Retinal fundus photograph; modified Davis grading:
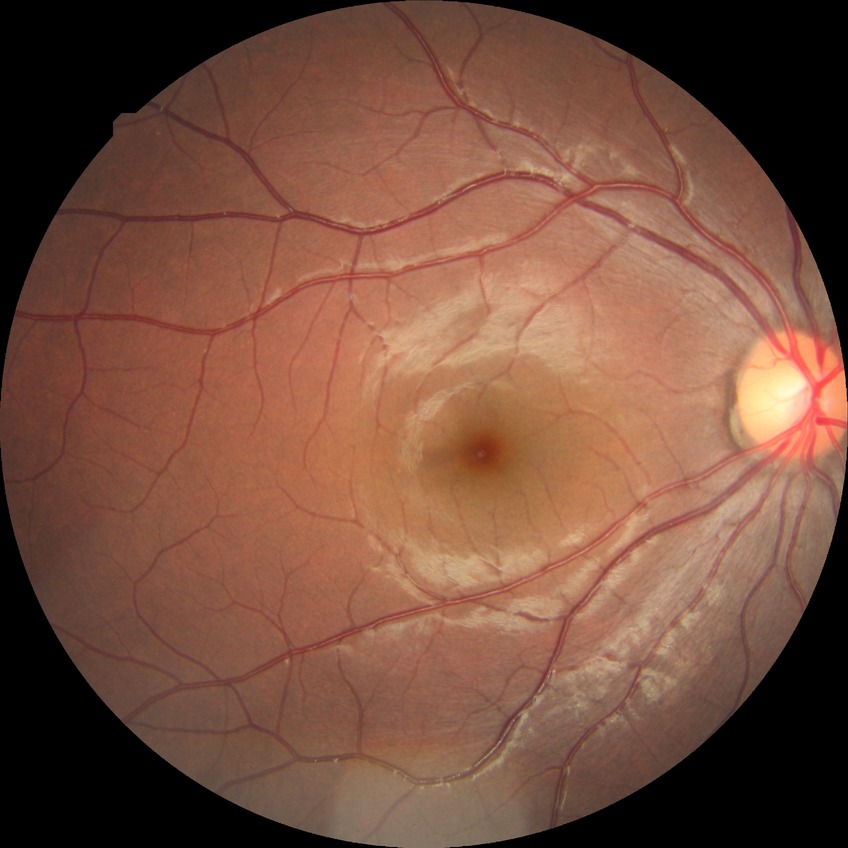

Diabetic retinopathy stage: no diabetic retinopathy.